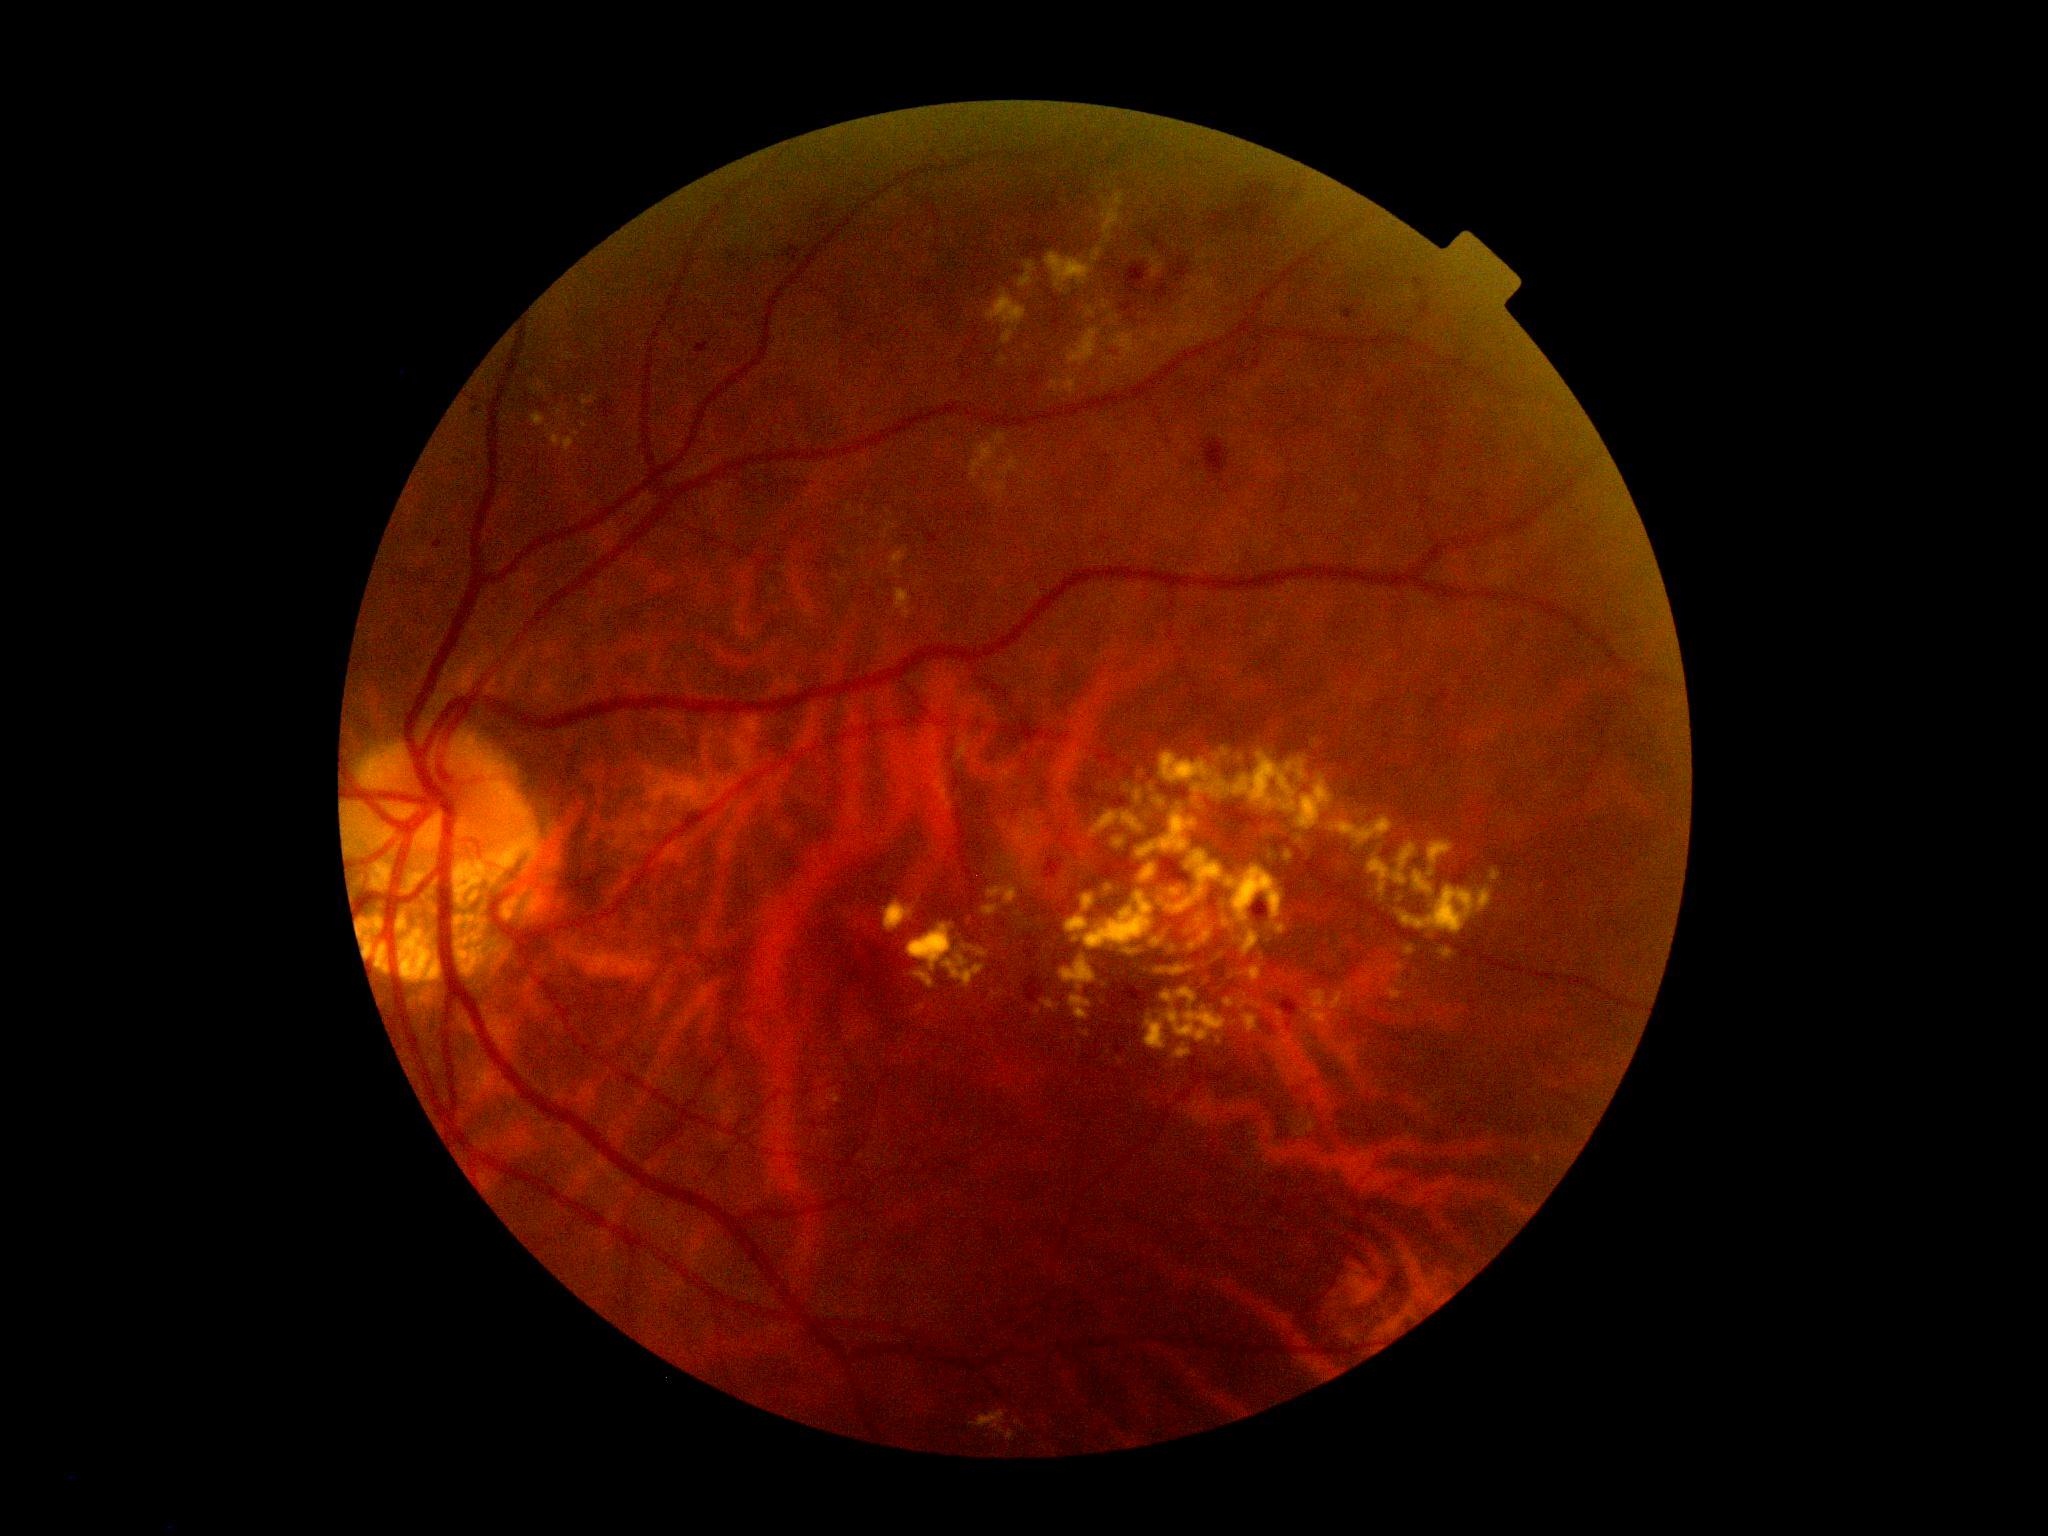

Retinopathy is moderate NPDR (grade 2).